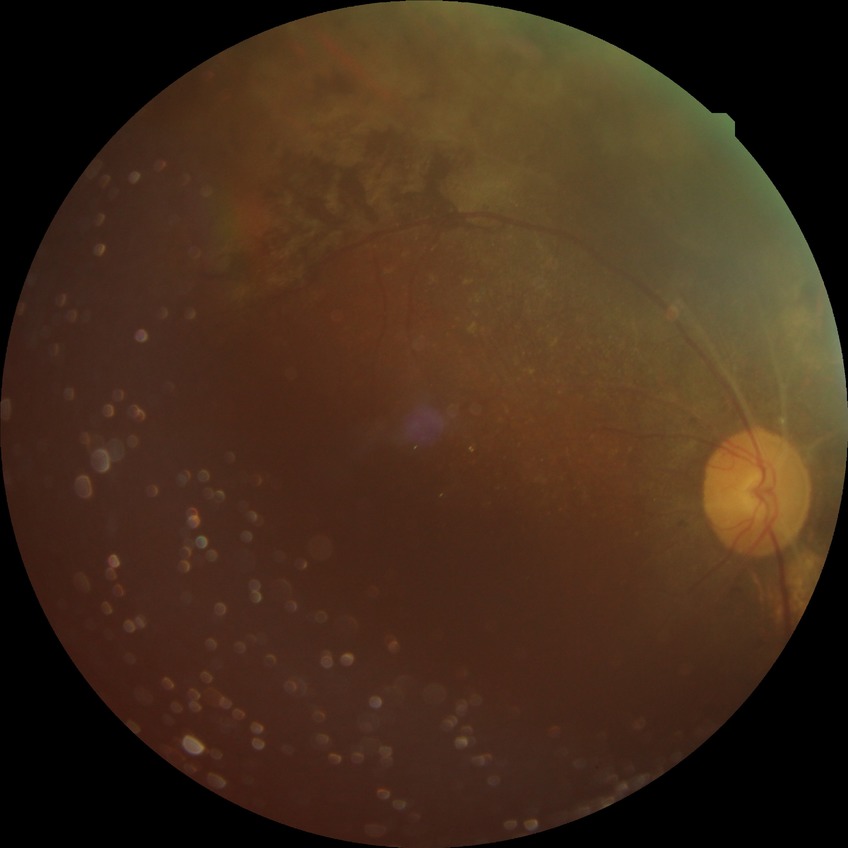 Diabetic retinopathy (DR): proliferative diabetic retinopathy (PDR).